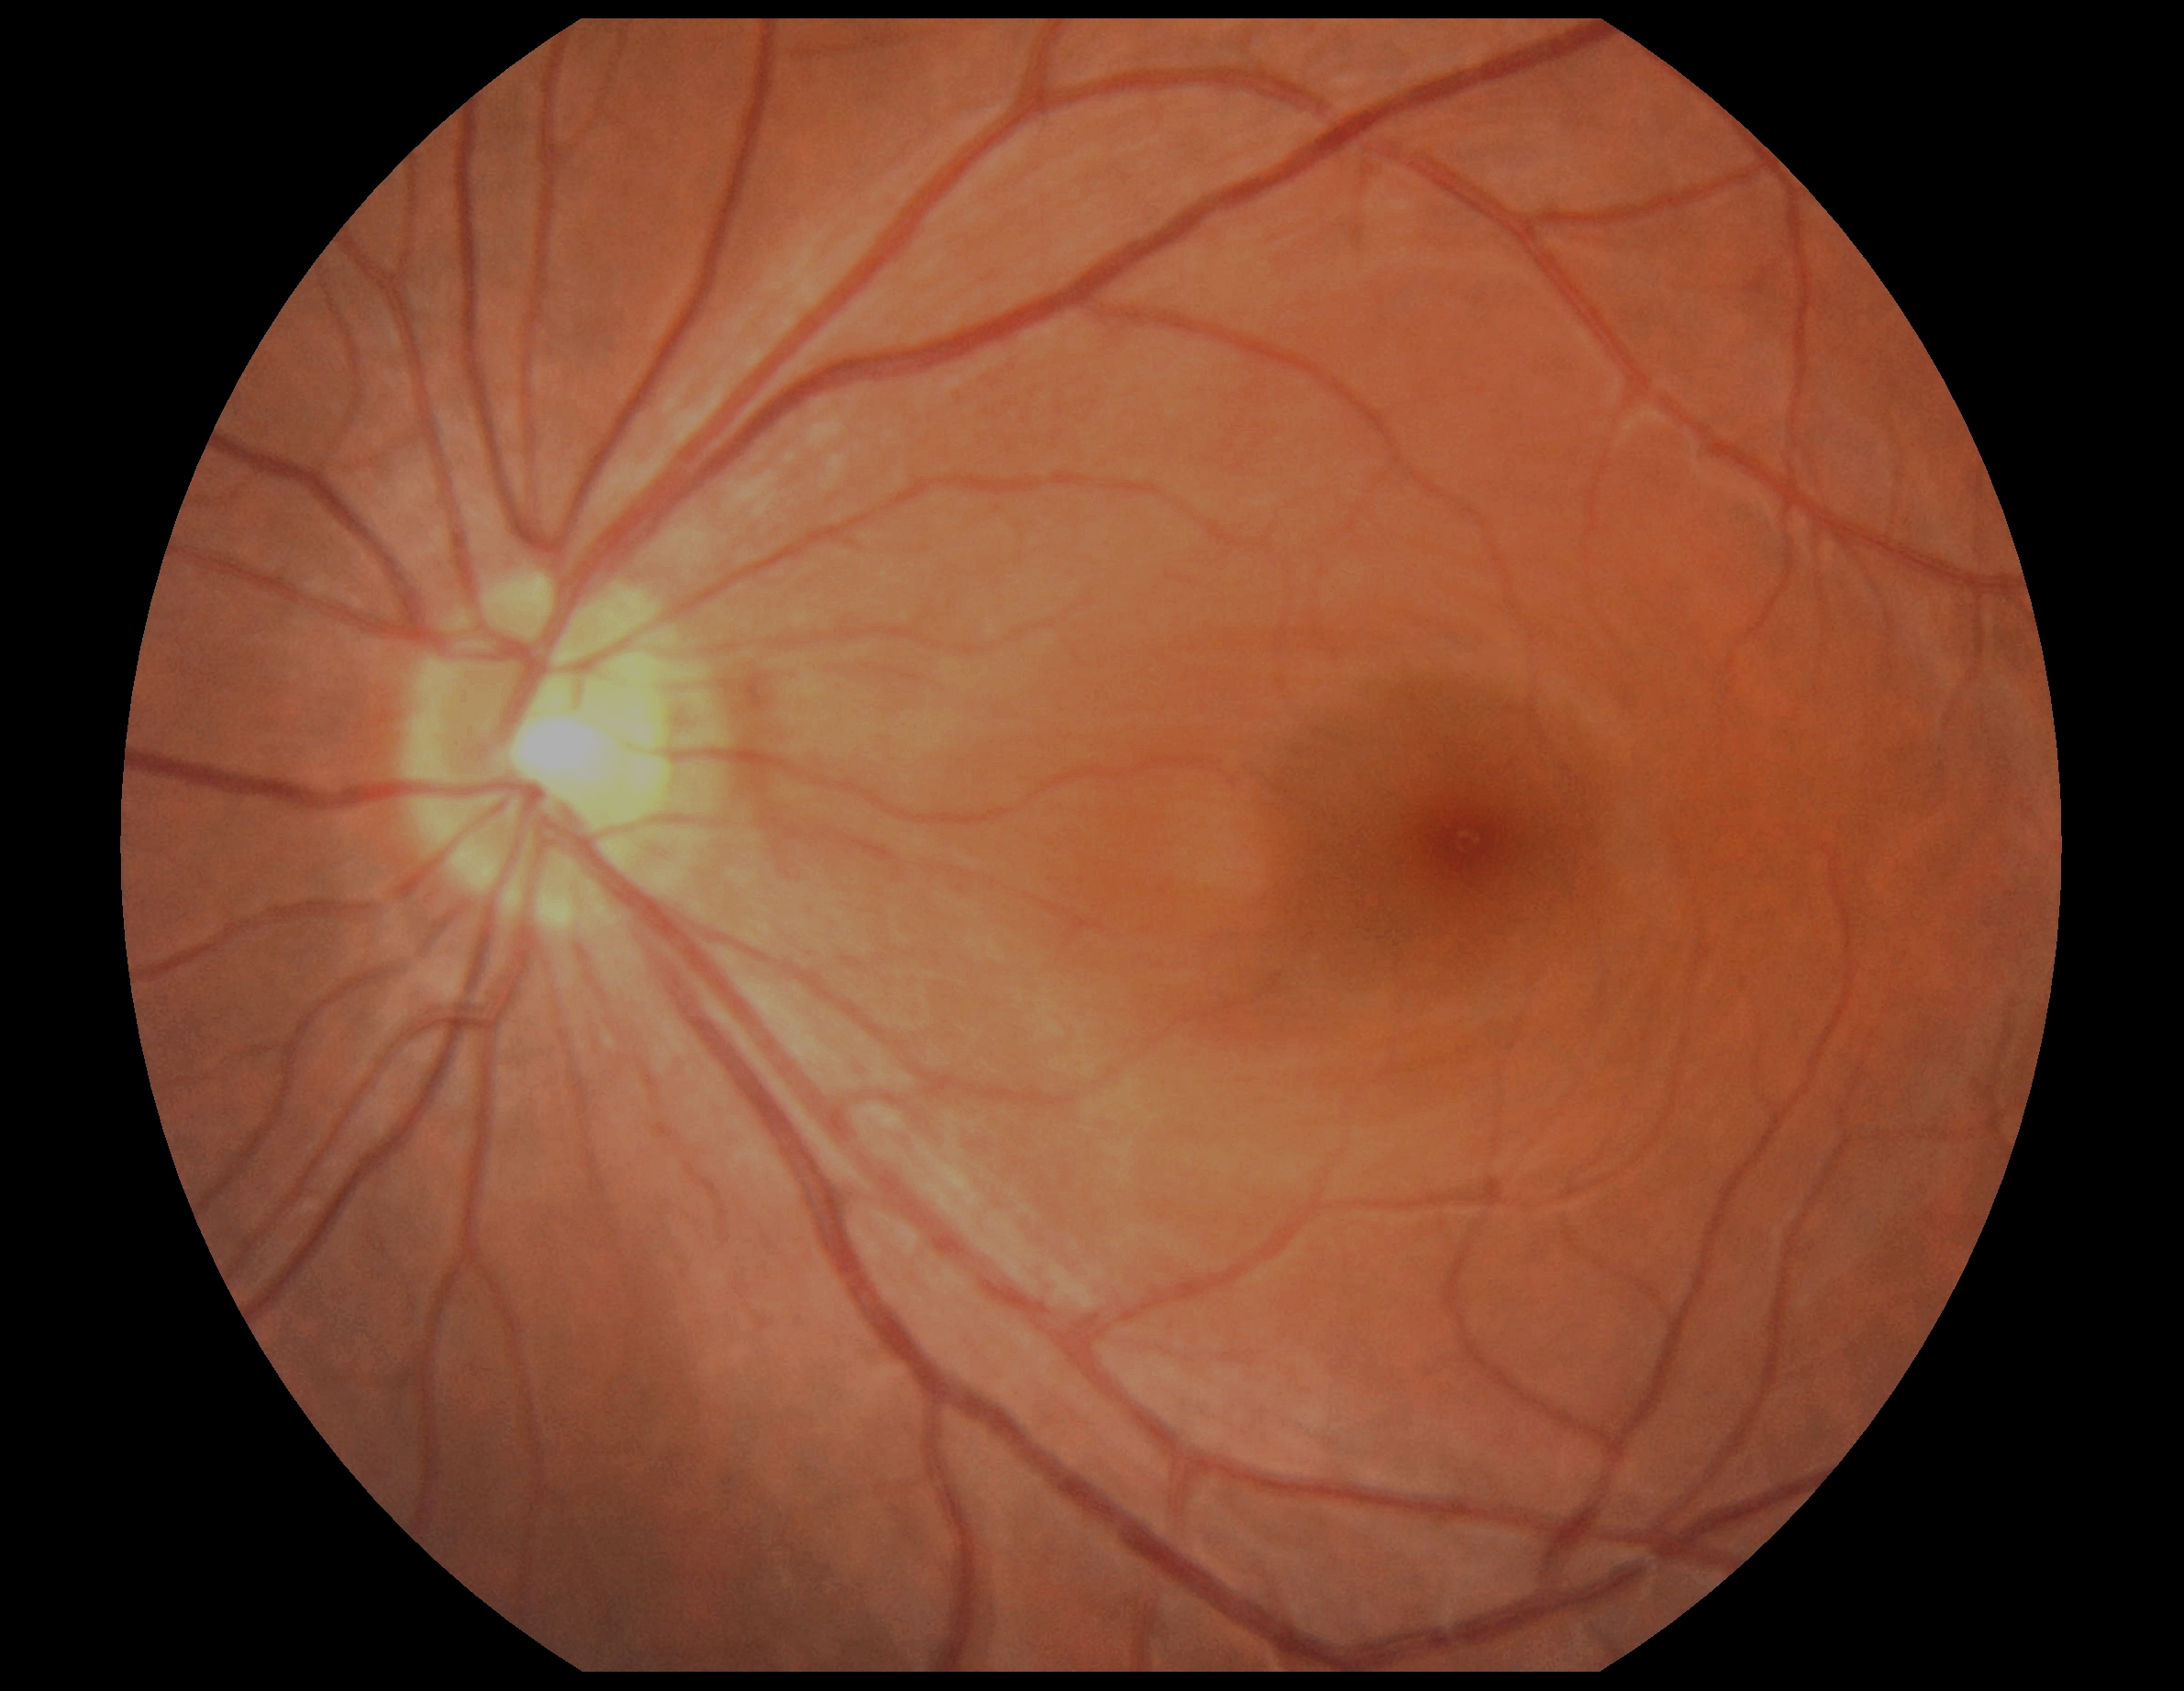 Diabetic retinopathy grade is no apparent diabetic retinopathy (0).